45° FOV.
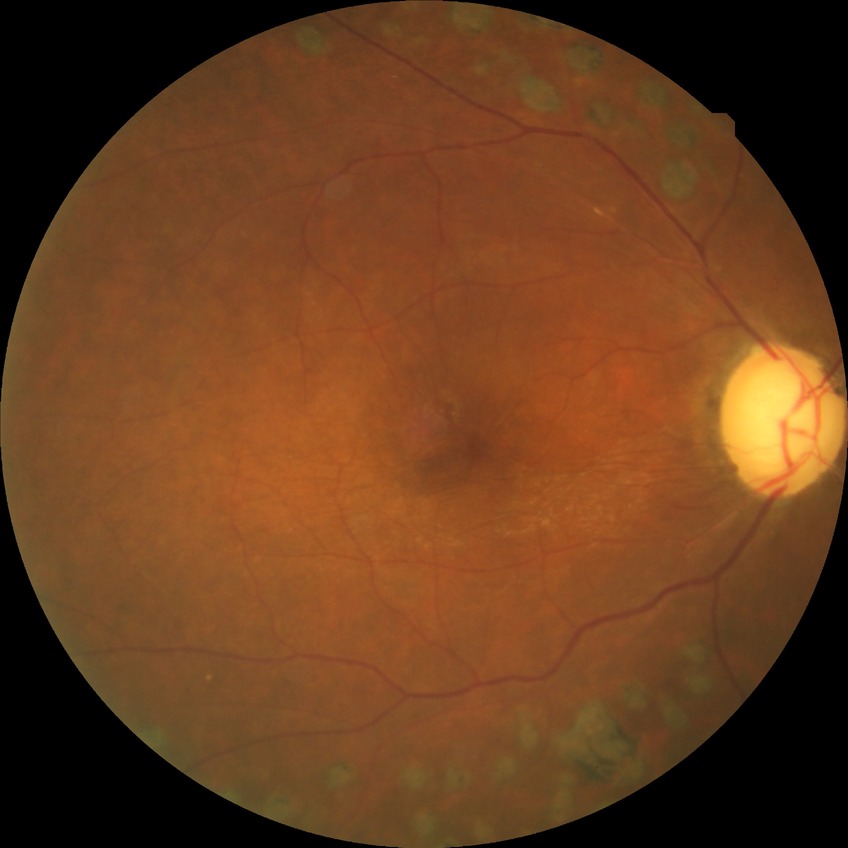
Retinopathy stage: no diabetic retinopathy.